45° field of view. 2212 by 1659 pixels
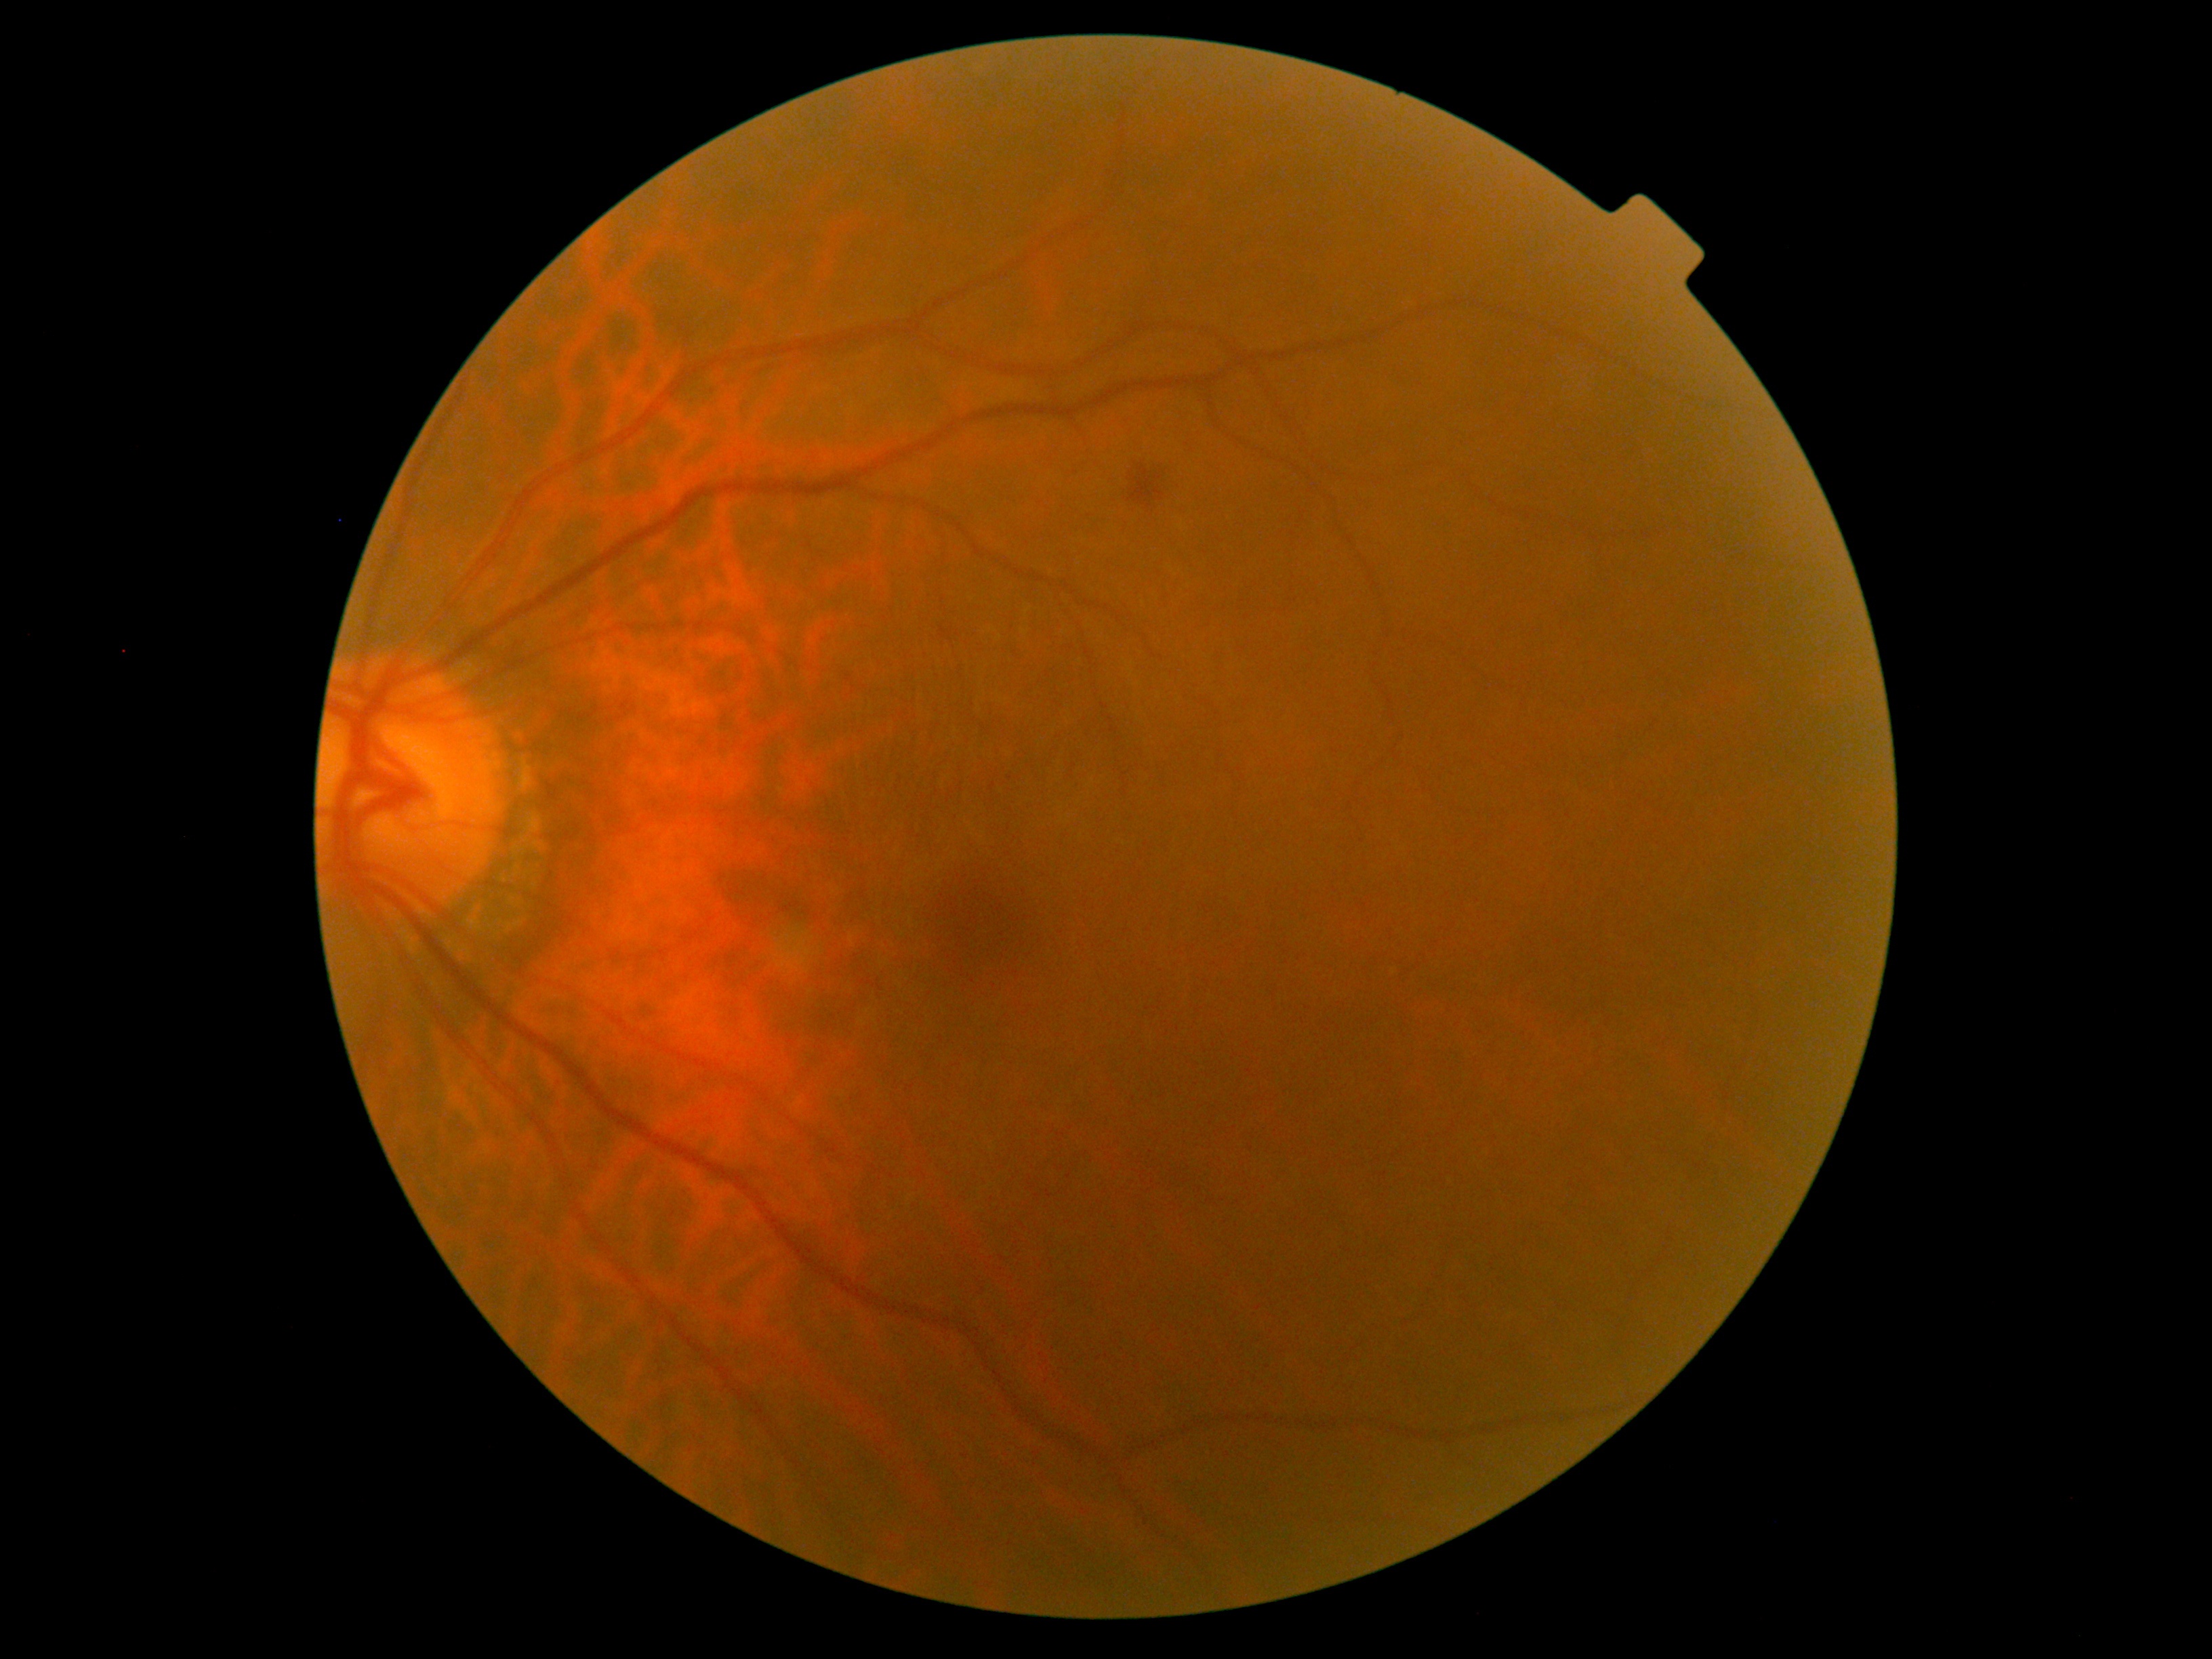

Retinopathy grade is 2 (moderate NPDR).